848x848 · NIDEK AFC-230 fundus camera · 45° field of view · color fundus image.
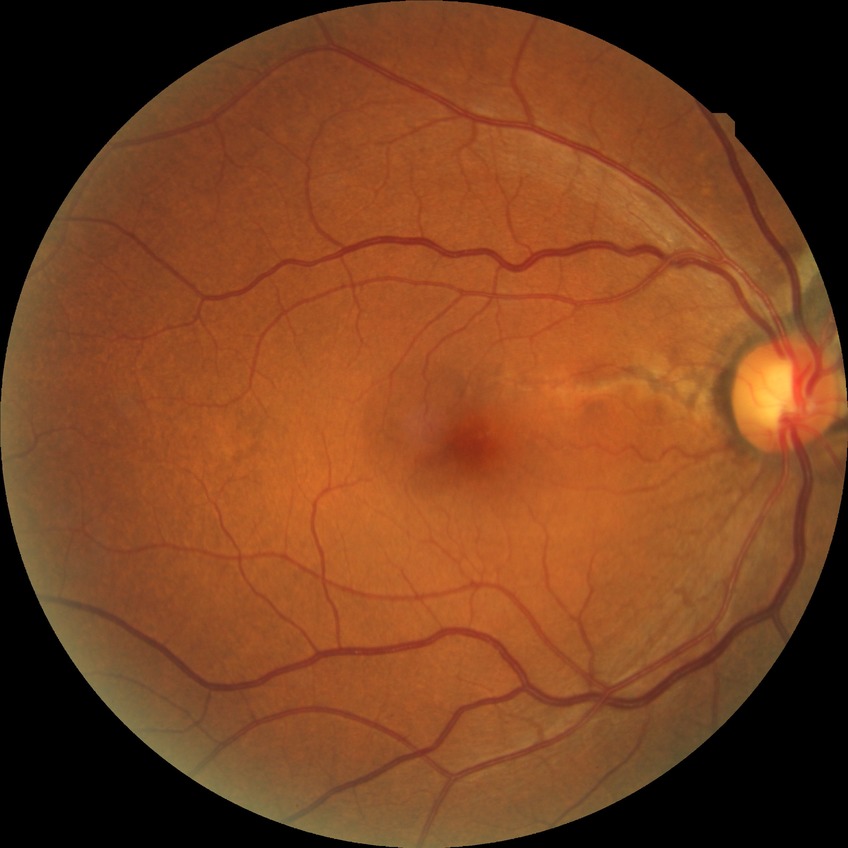

{
  "davis_grade": "NDR",
  "dr_impression": "no signs of DR"
}